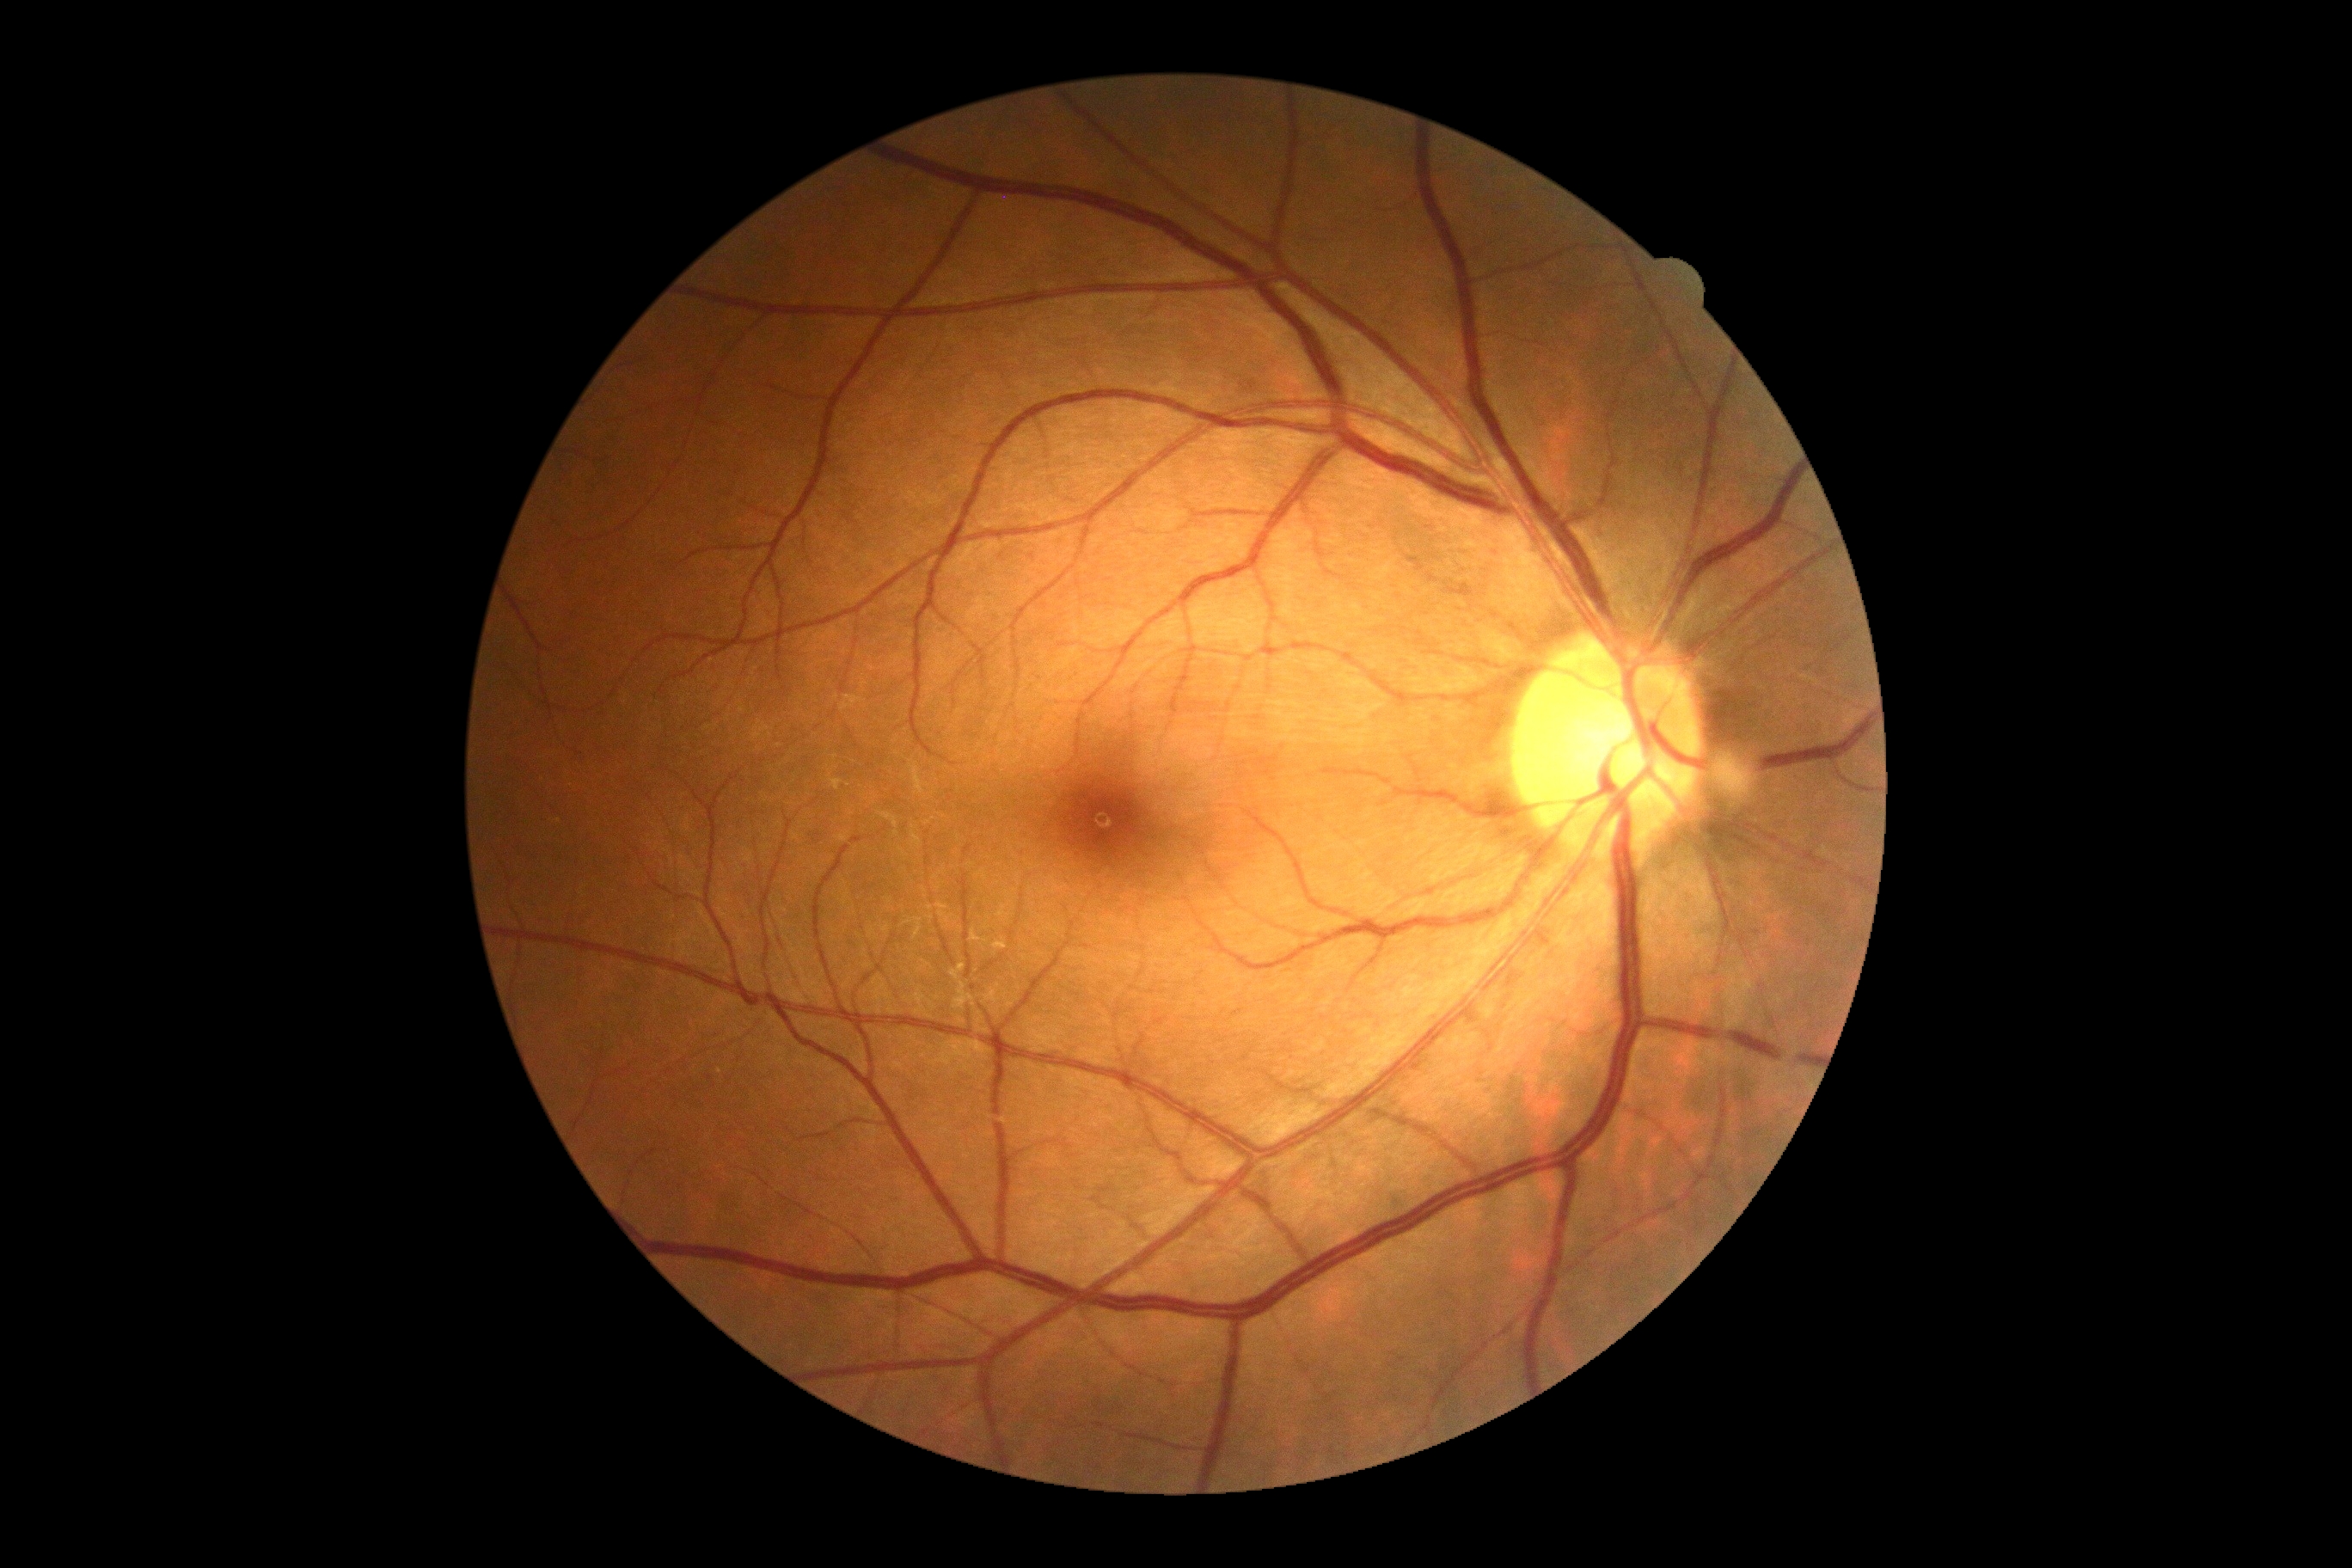

DR stage: 0.